Color fundus photograph: 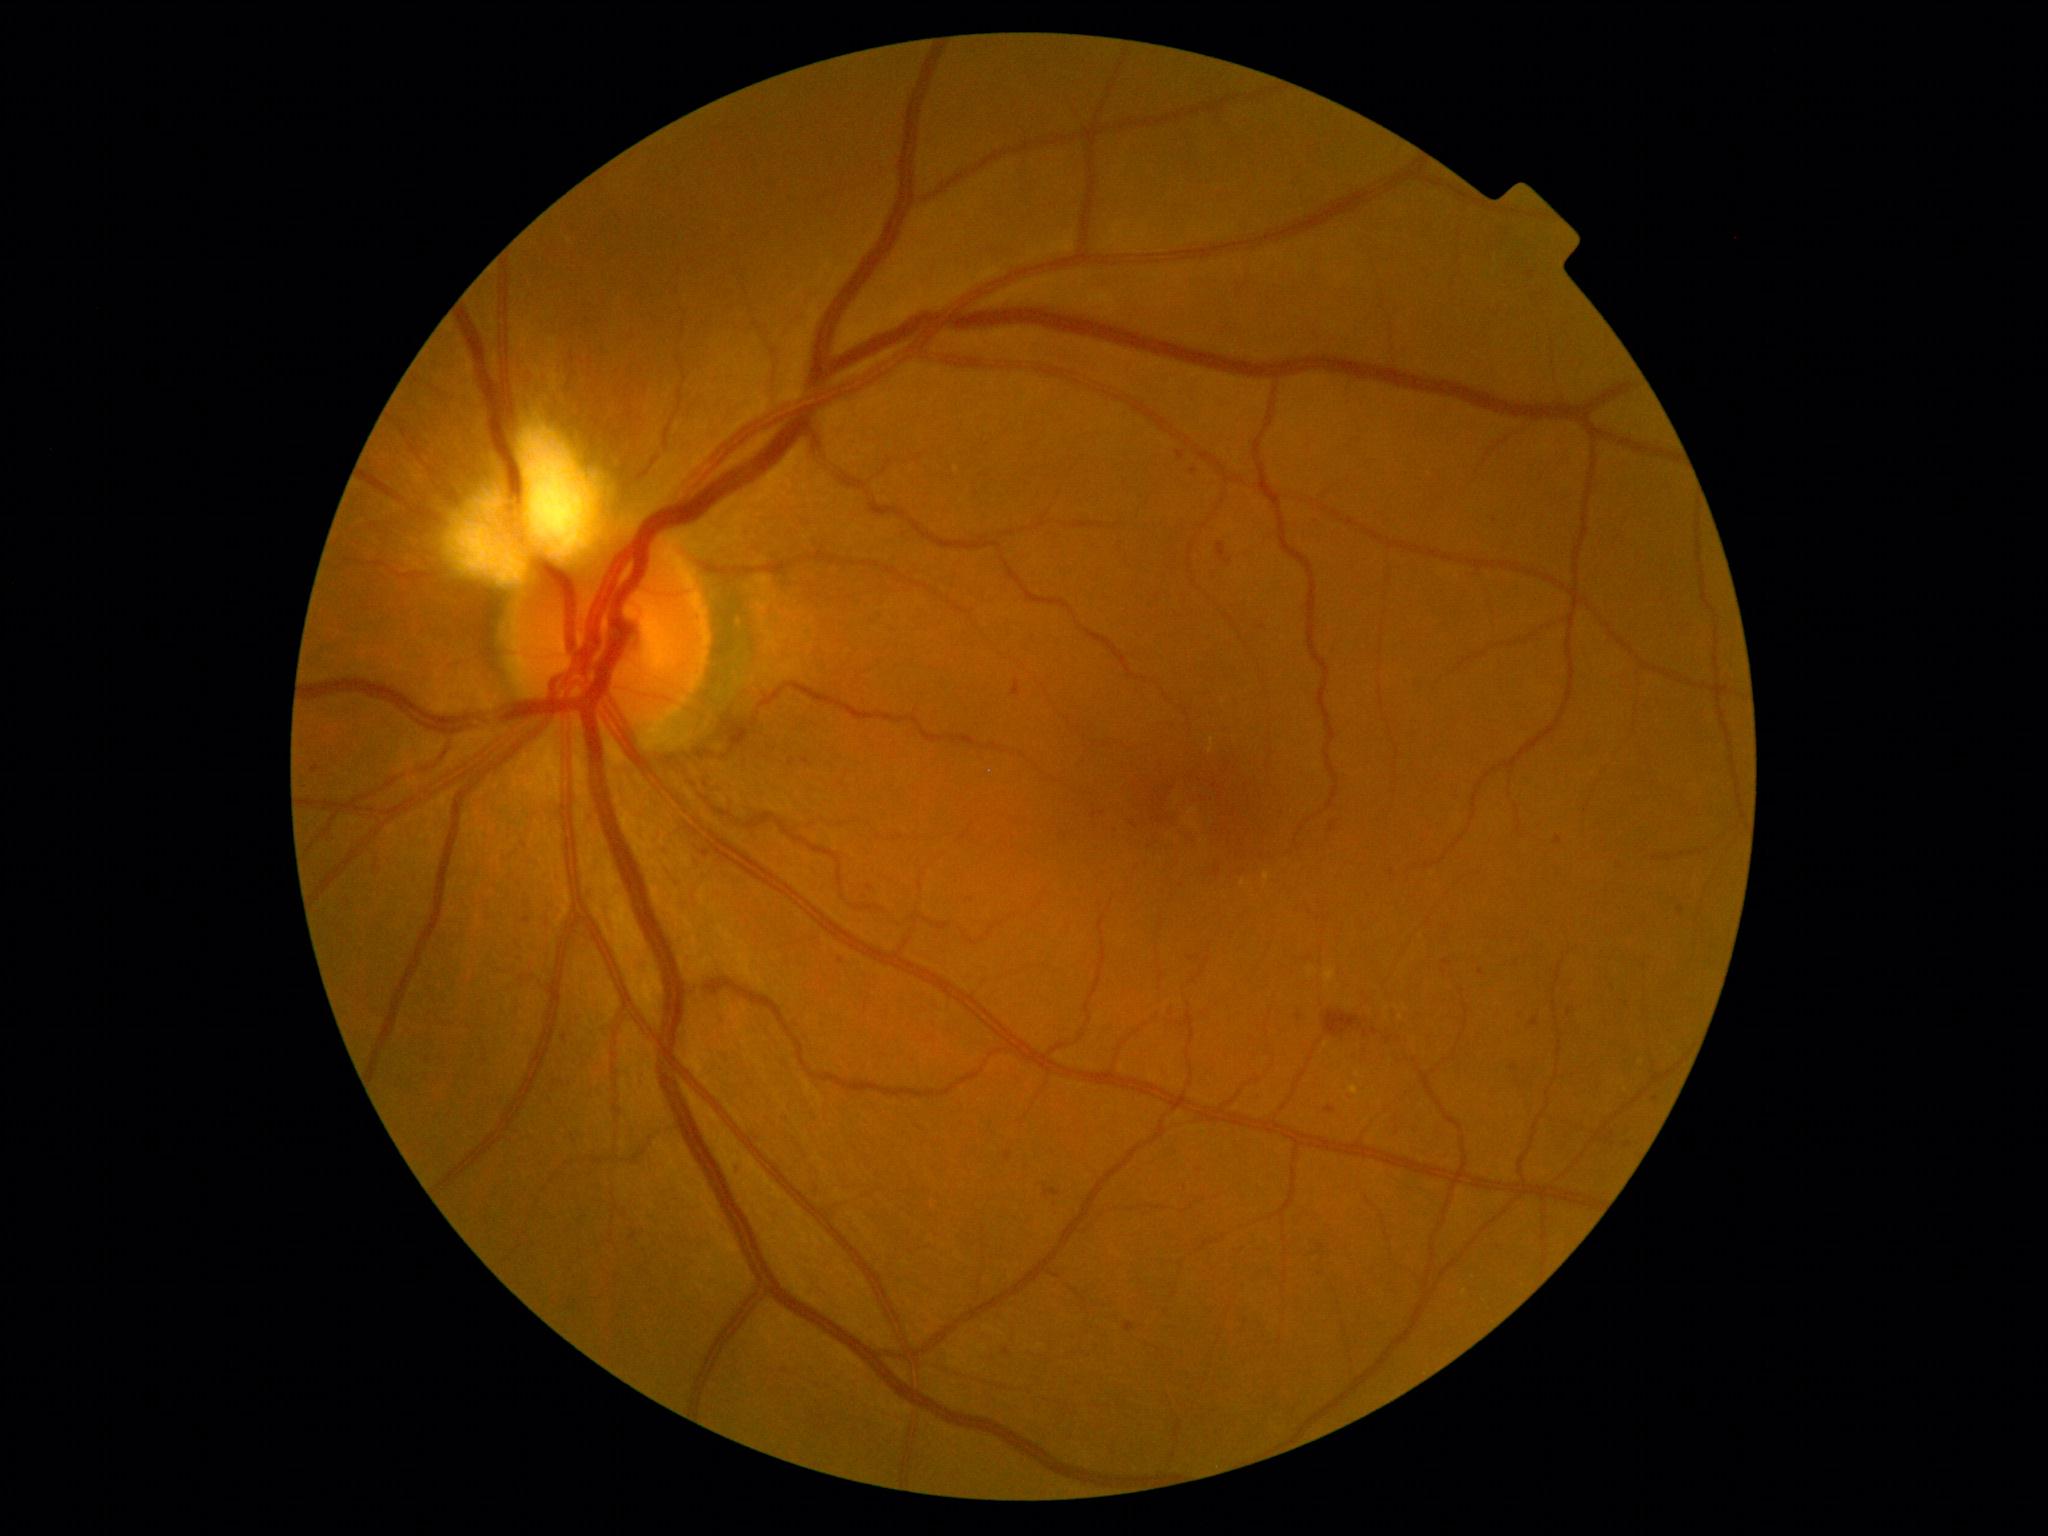

Diabetic retinopathy severity: moderate non-proliferative diabetic retinopathy (grade 2) — more than just microaneurysms but less than severe NPDR.